1440x1080 · pediatric retinal photograph (wide-field) · Natus RetCam Envision, 130° FOV: 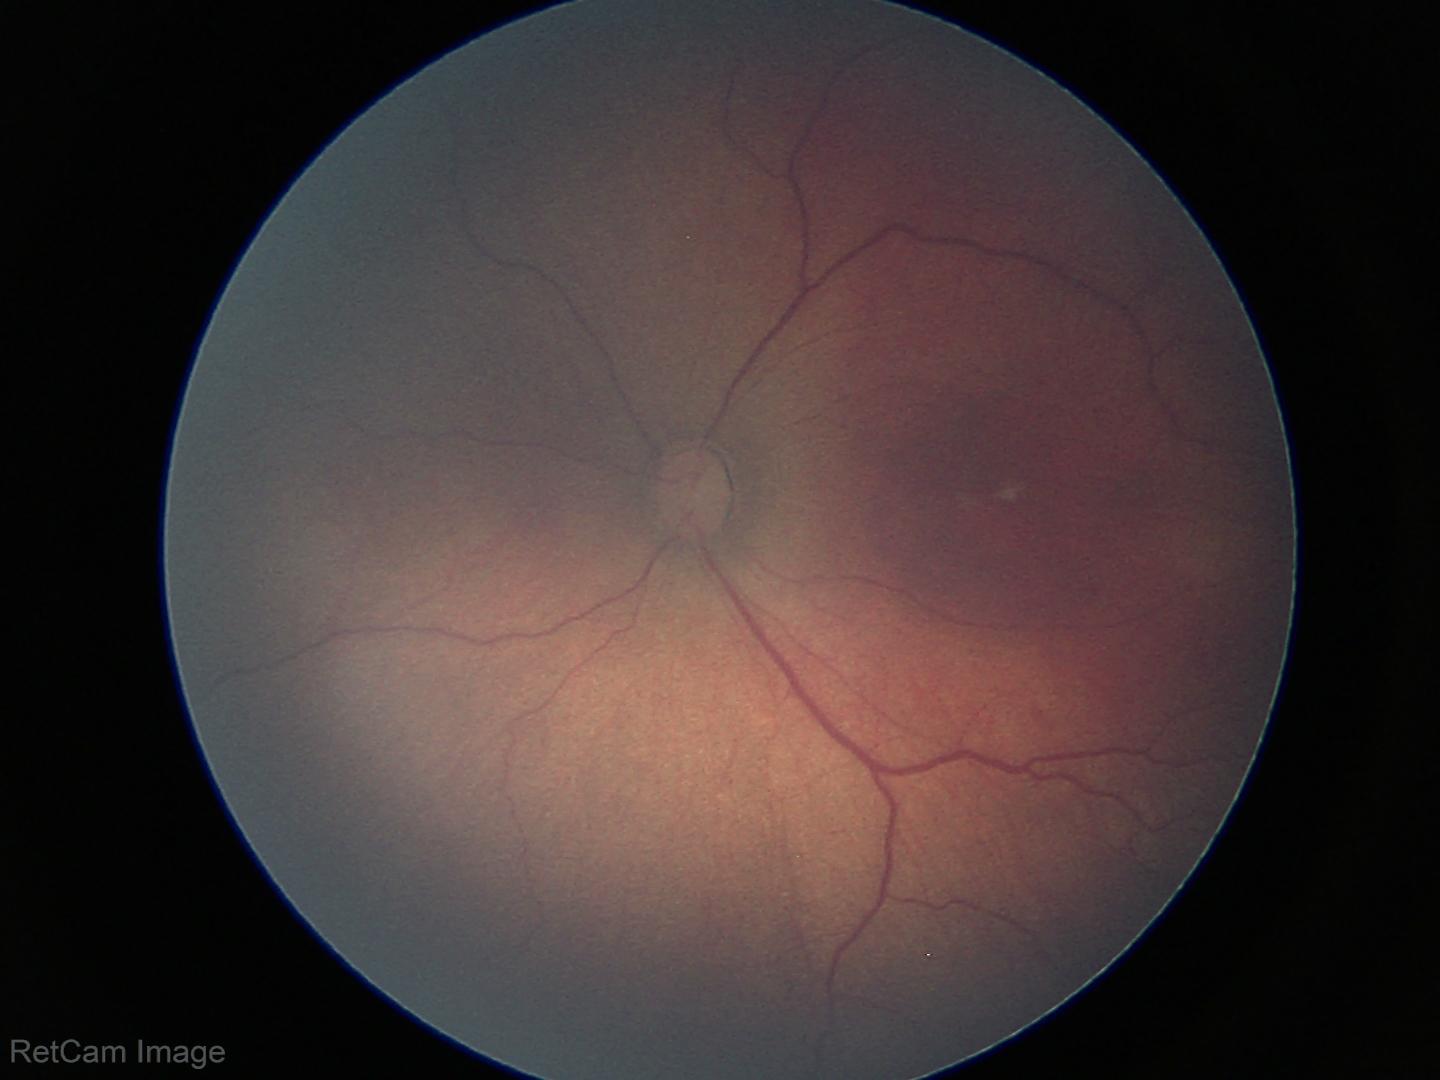 Screening series with ROP stage 3.
Plus disease absent.